848x848px. 45° field of view
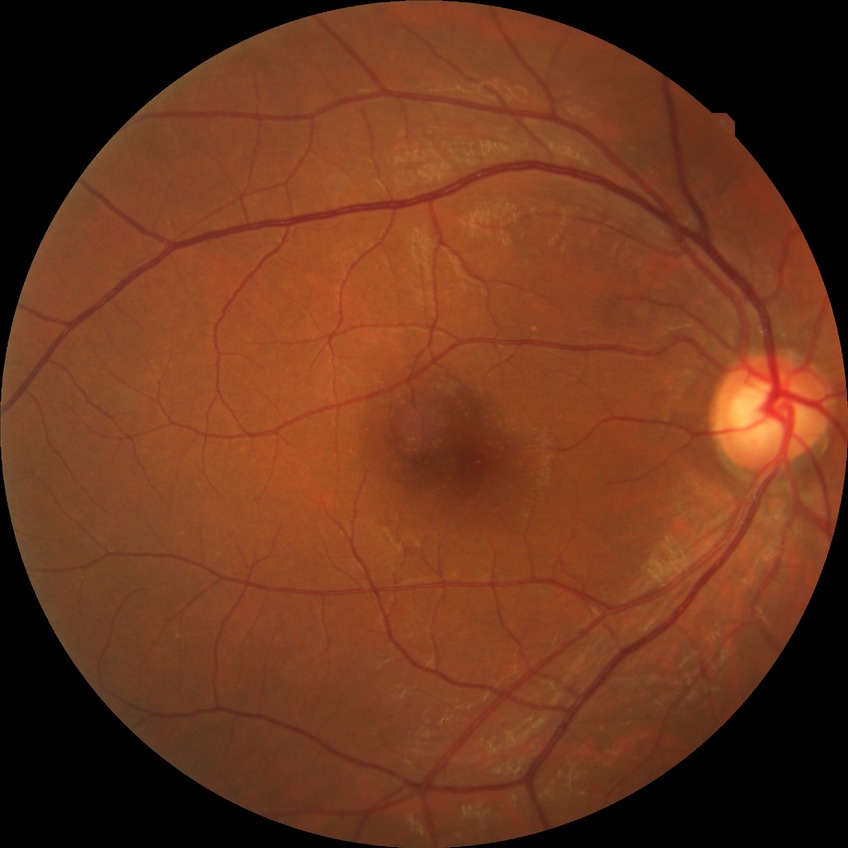

Assessment:
• Davis DR grade — NDR